2352 x 1568 pixels. 45° FOV. Fundus photo:
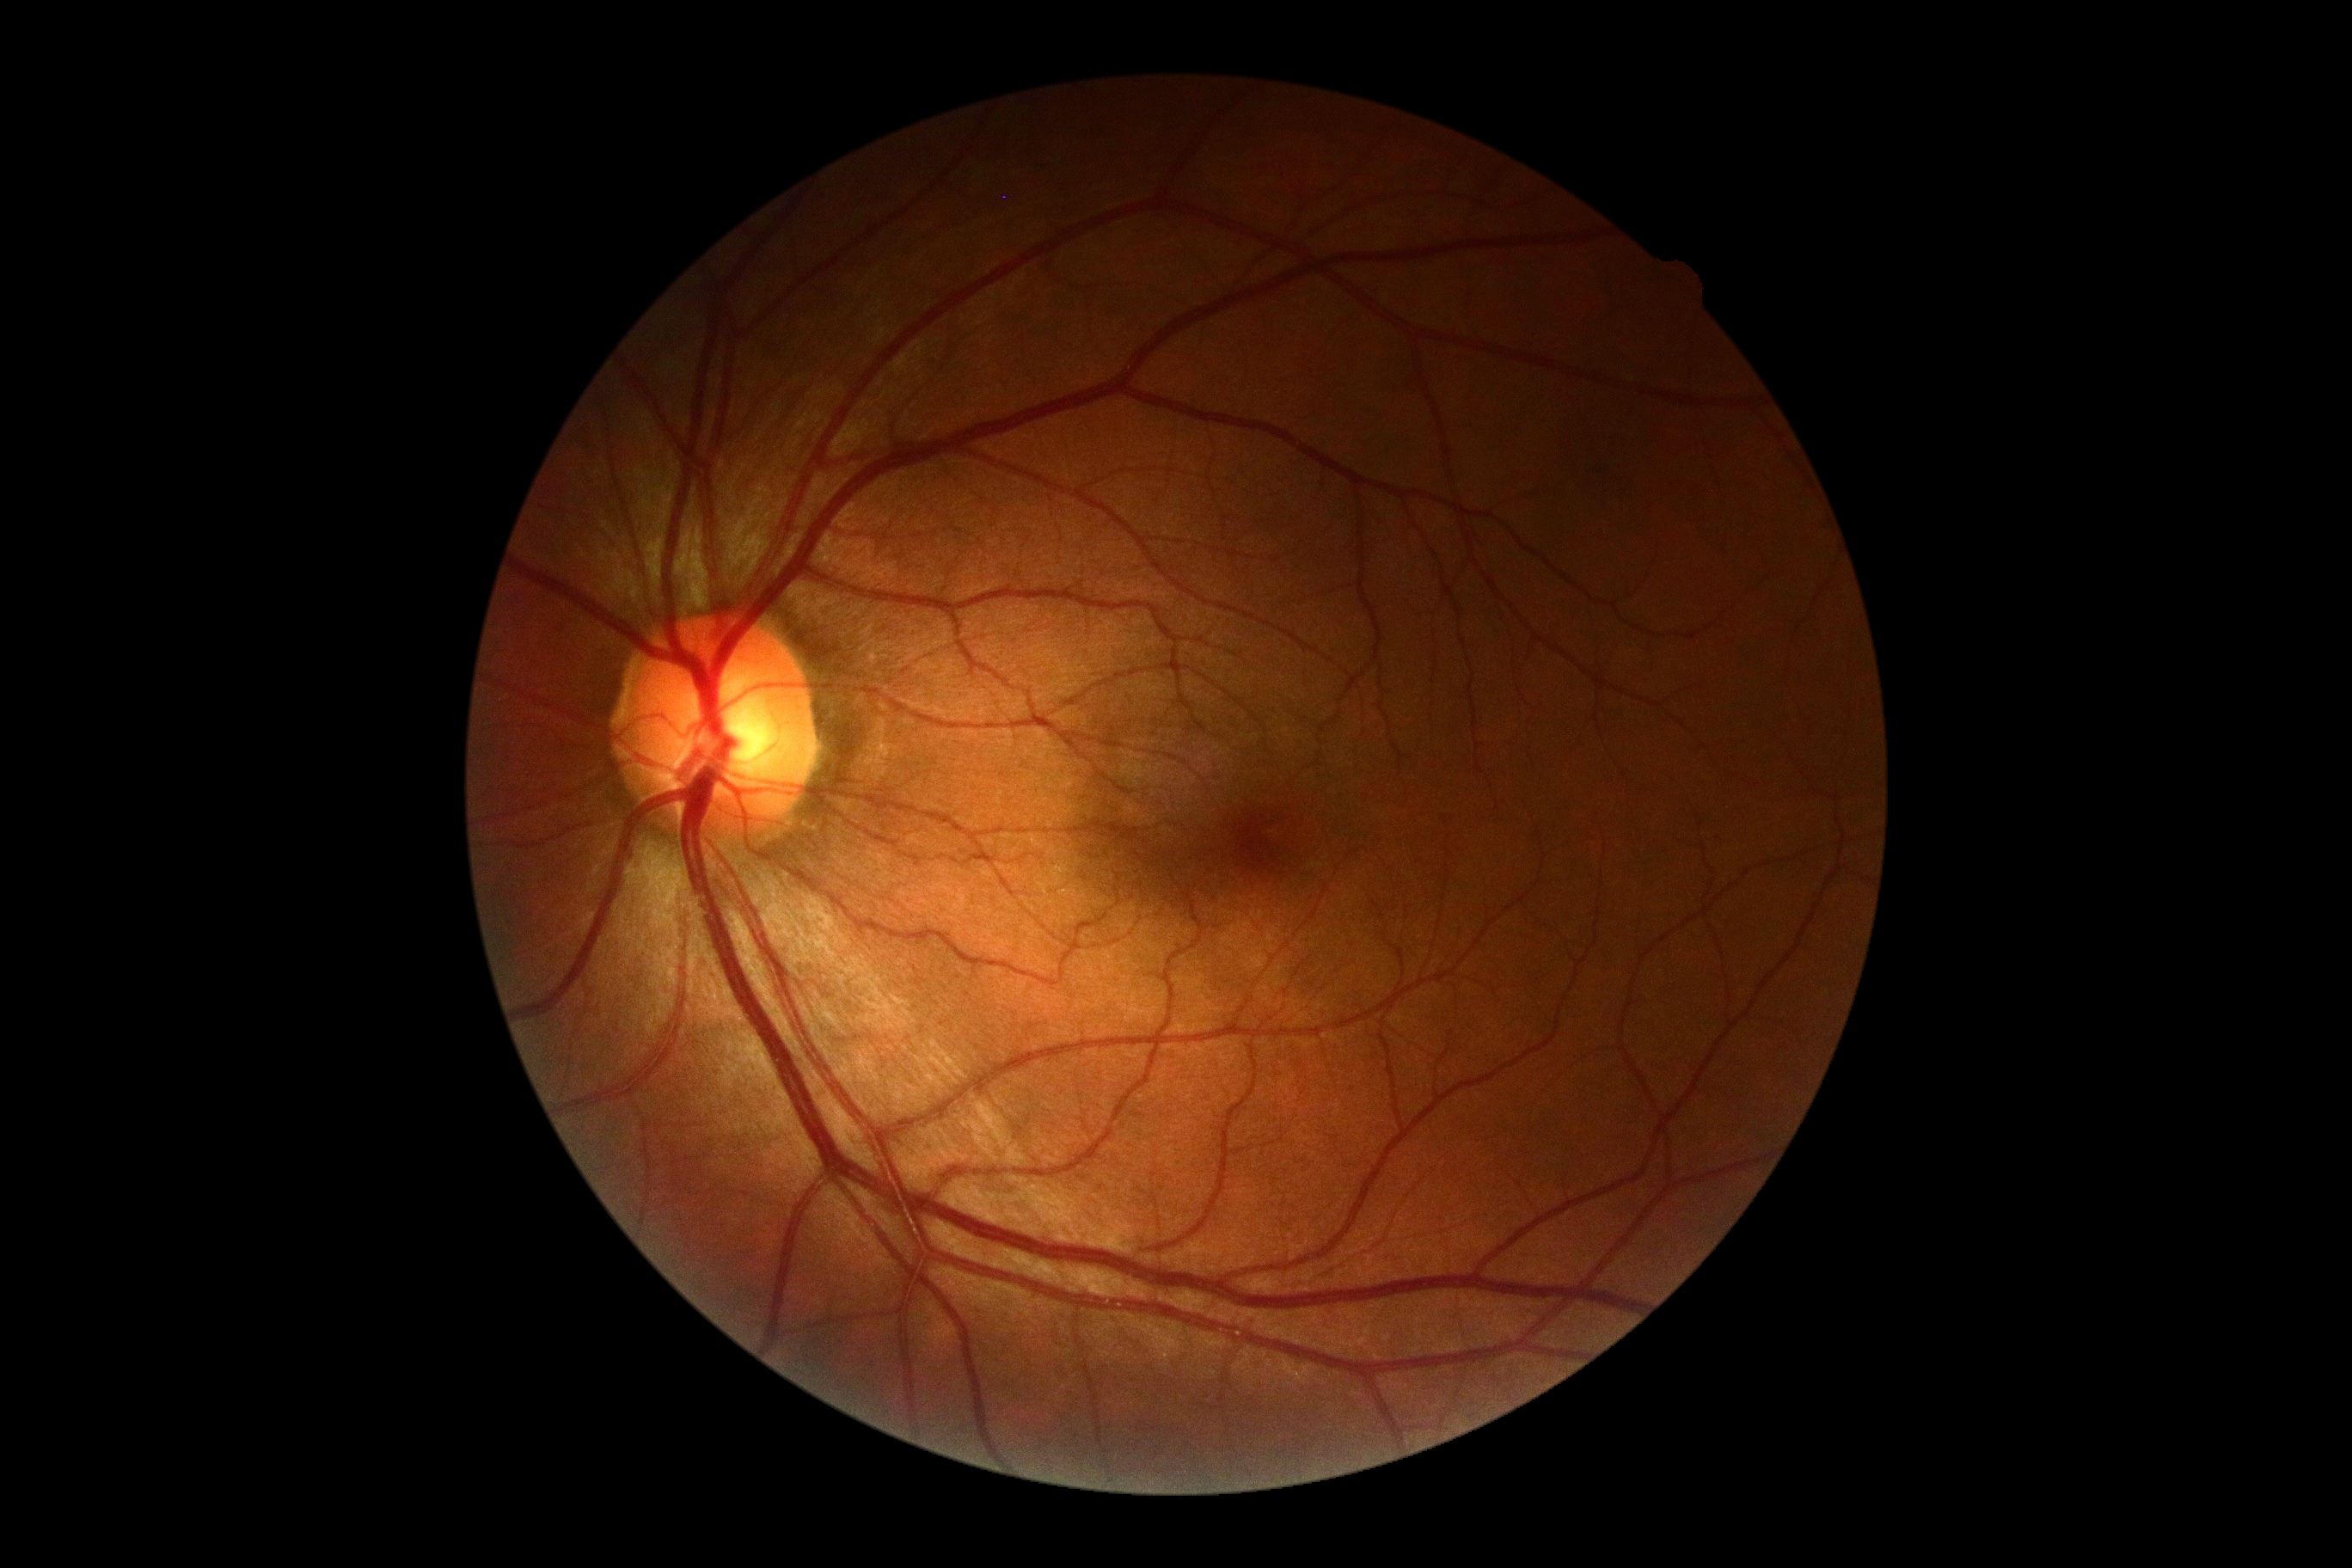 DR severity: no apparent diabetic retinopathy (grade 0). No DR findings.